CFP — 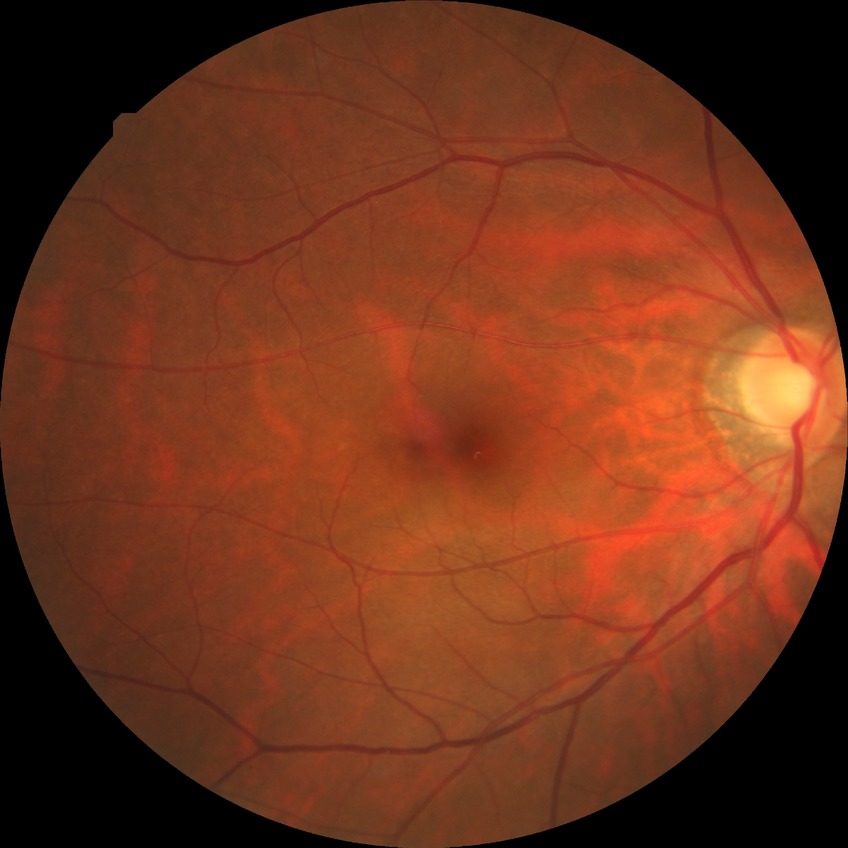

Diabetic retinopathy (DR) is no diabetic retinopathy (NDR).